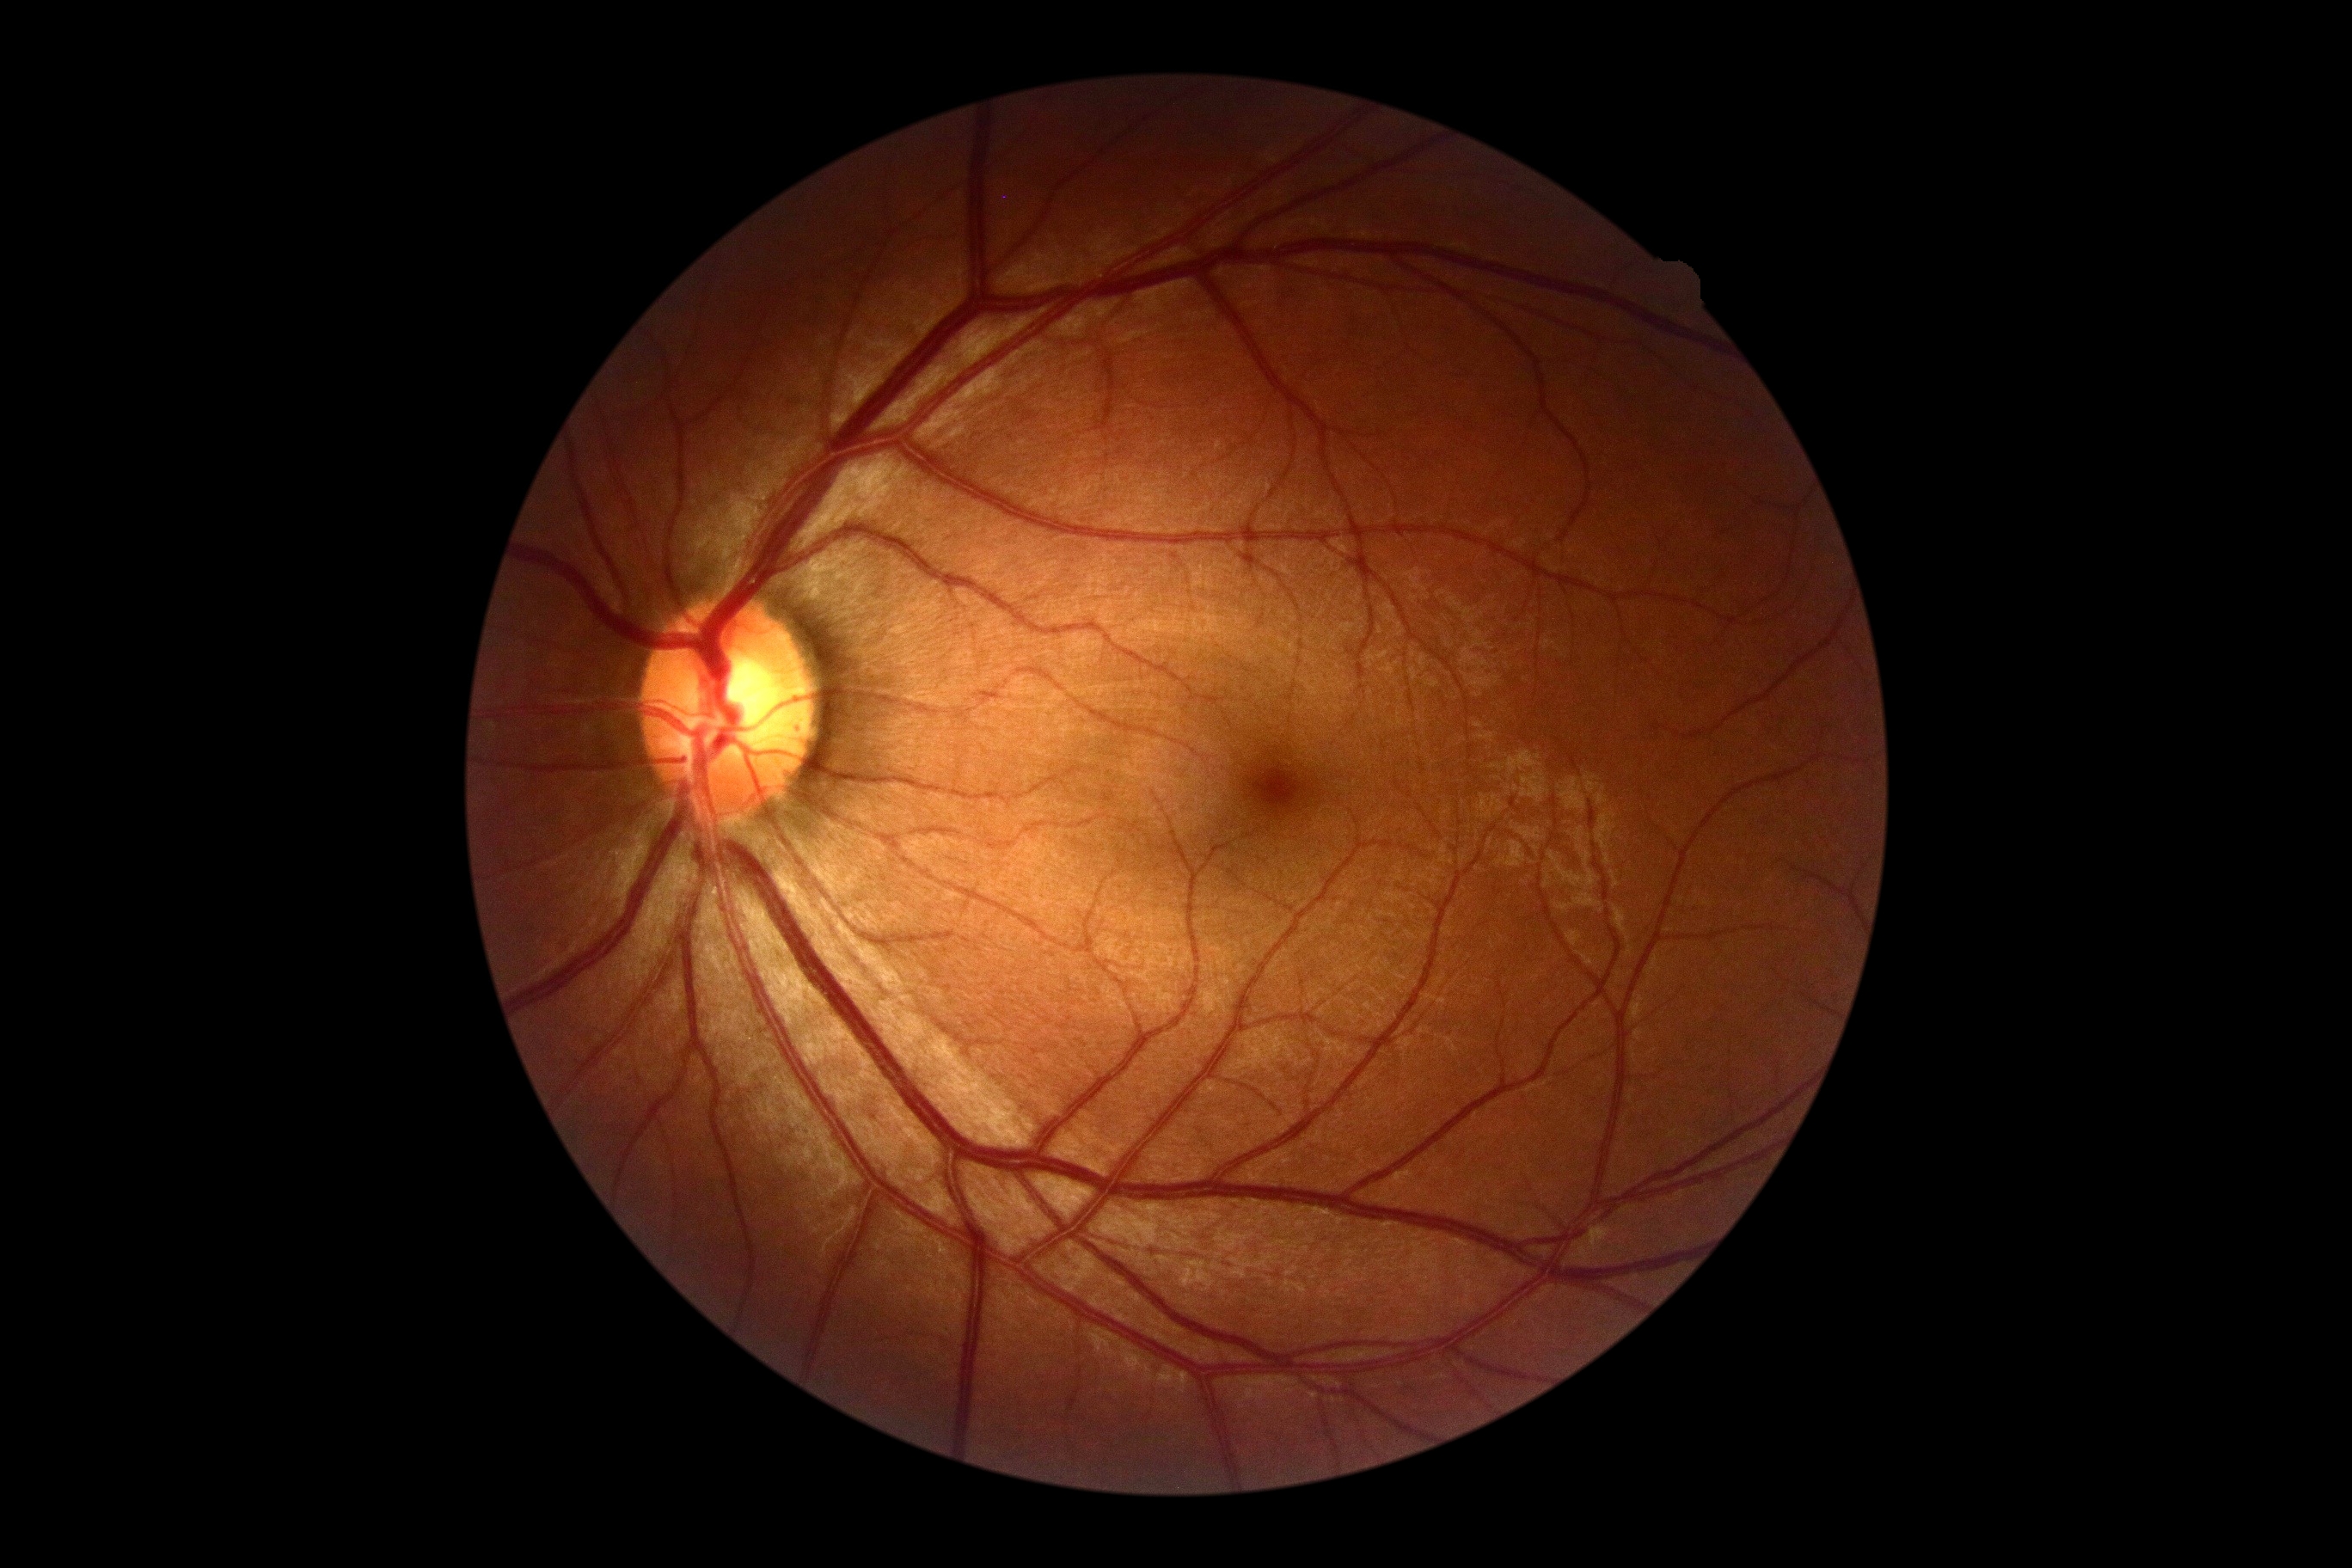

Diabetic retinopathy severity is grade 0 (no apparent retinopathy). No signs of diabetic retinopathy.